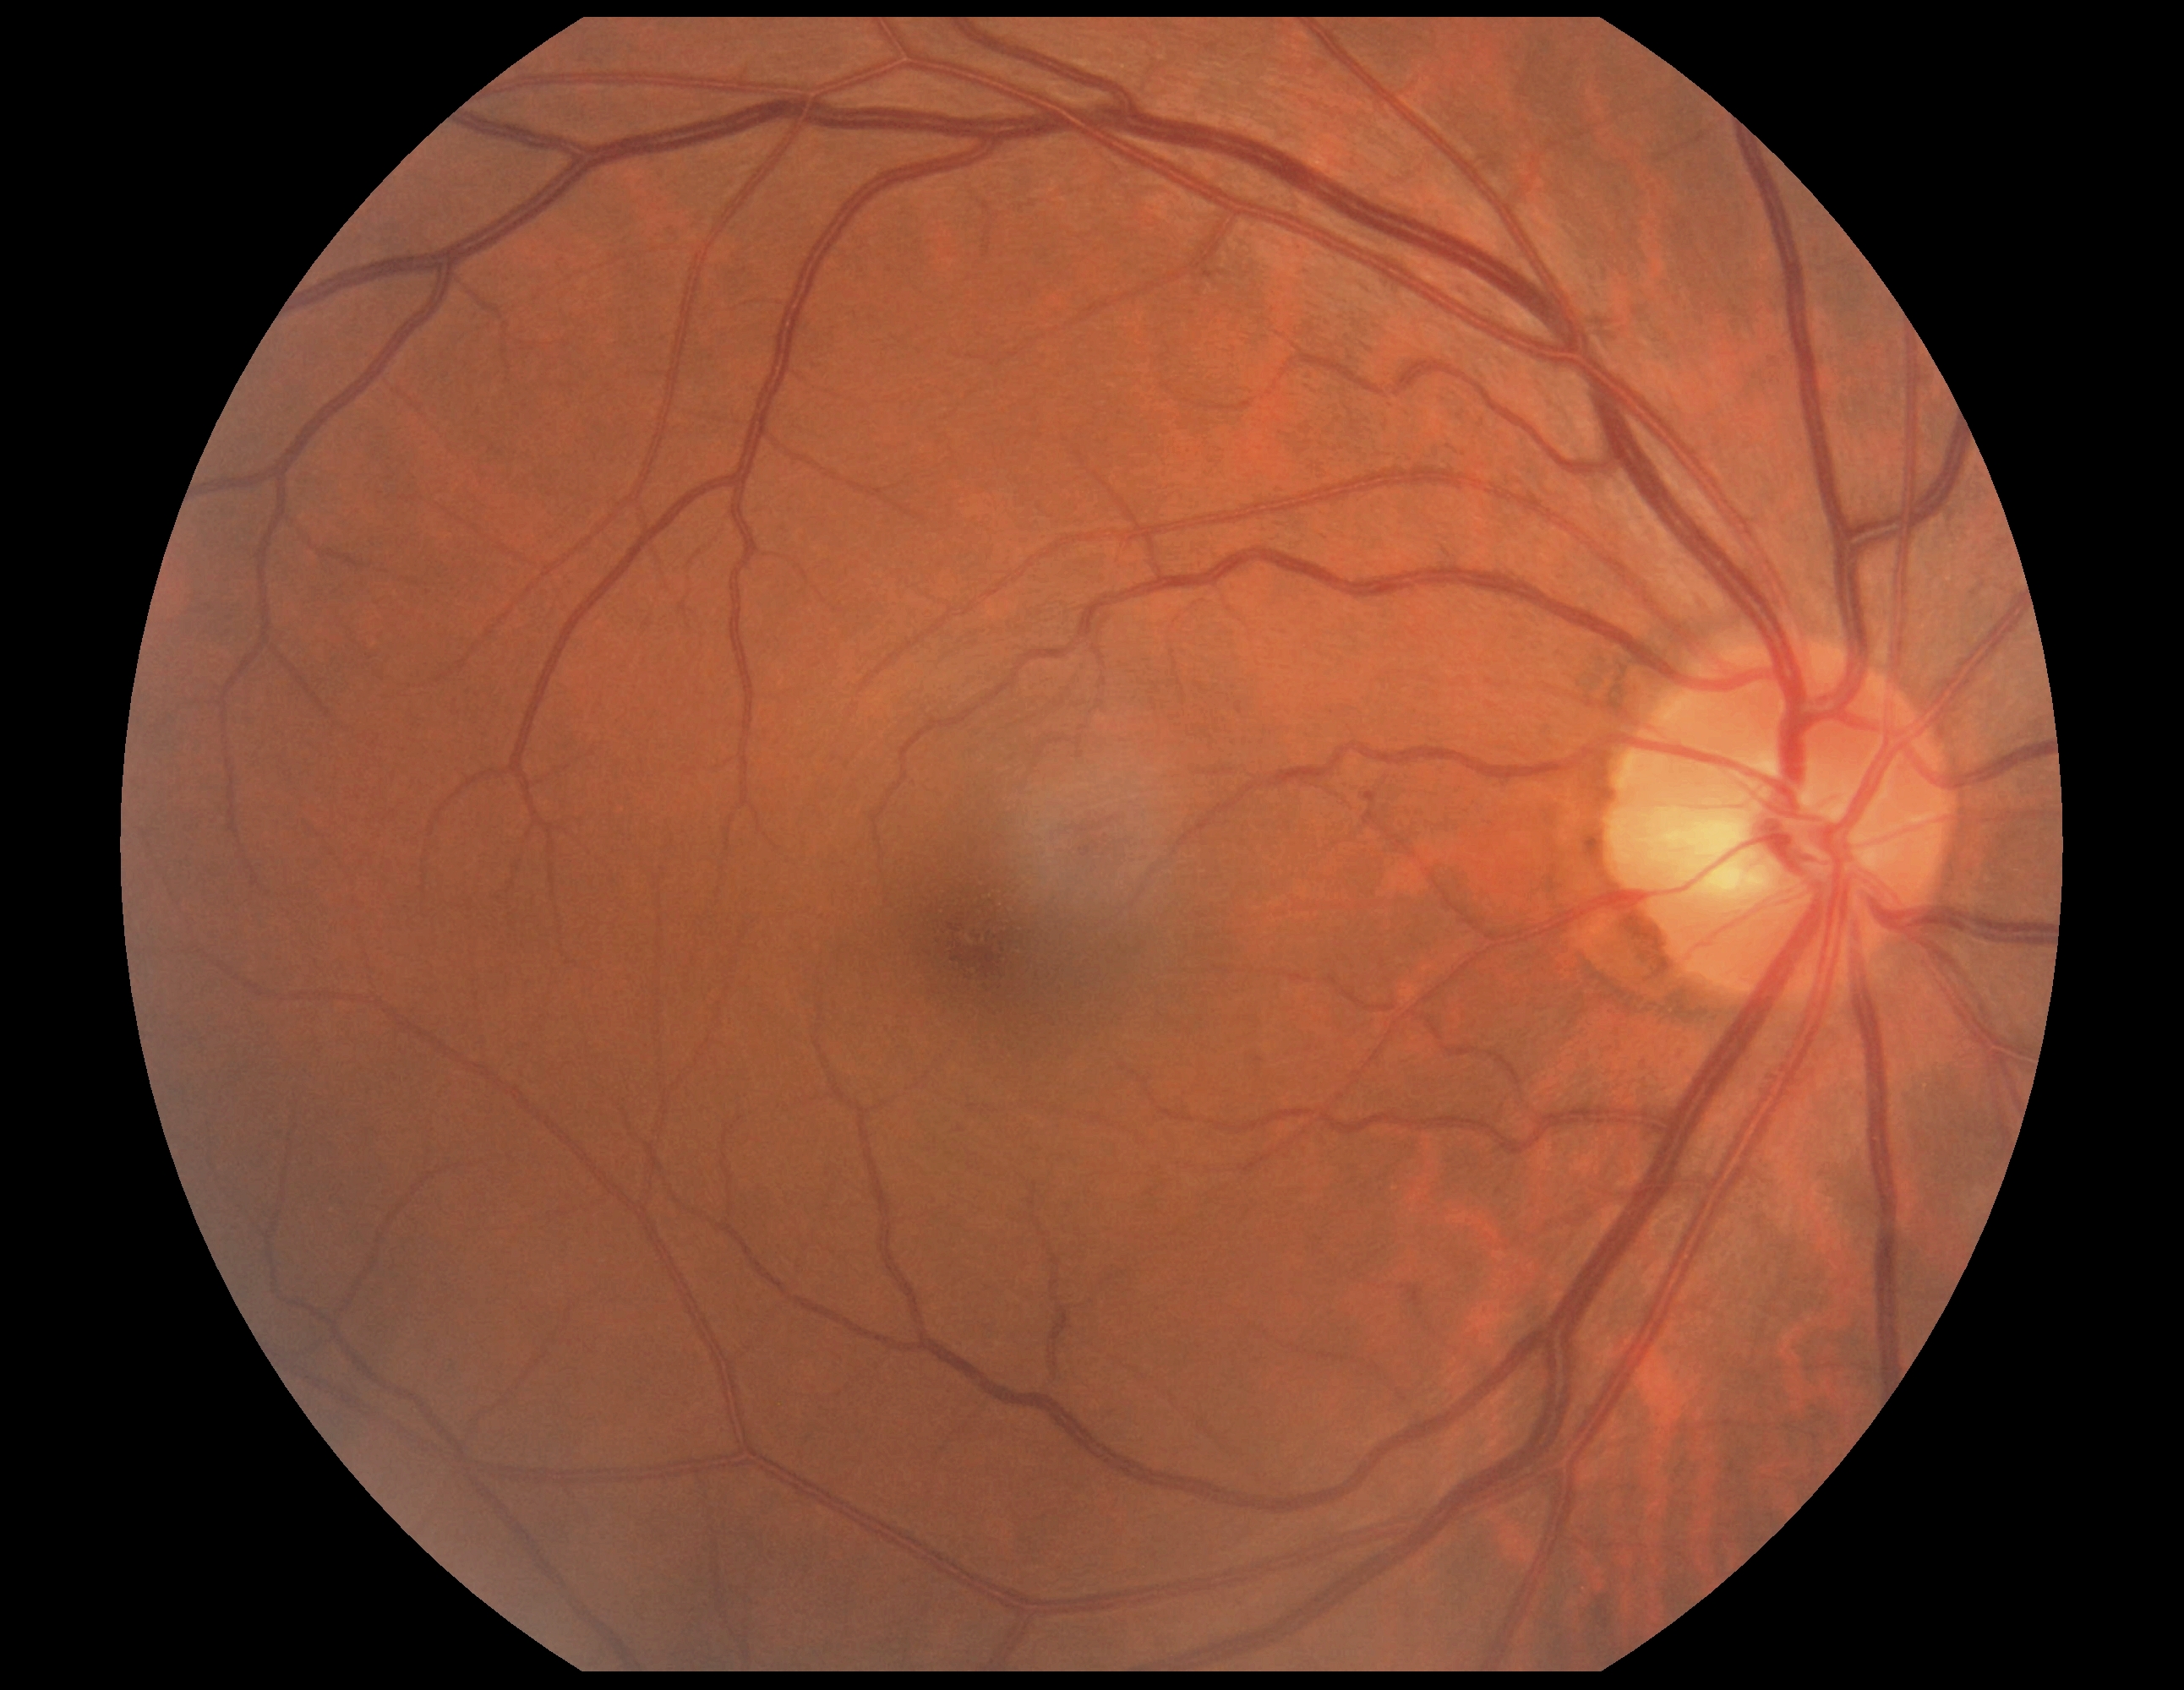 Retinopathy: no apparent retinopathy (grade 0). No diabetic retinal disease findings.